45-degree field of view; color fundus image
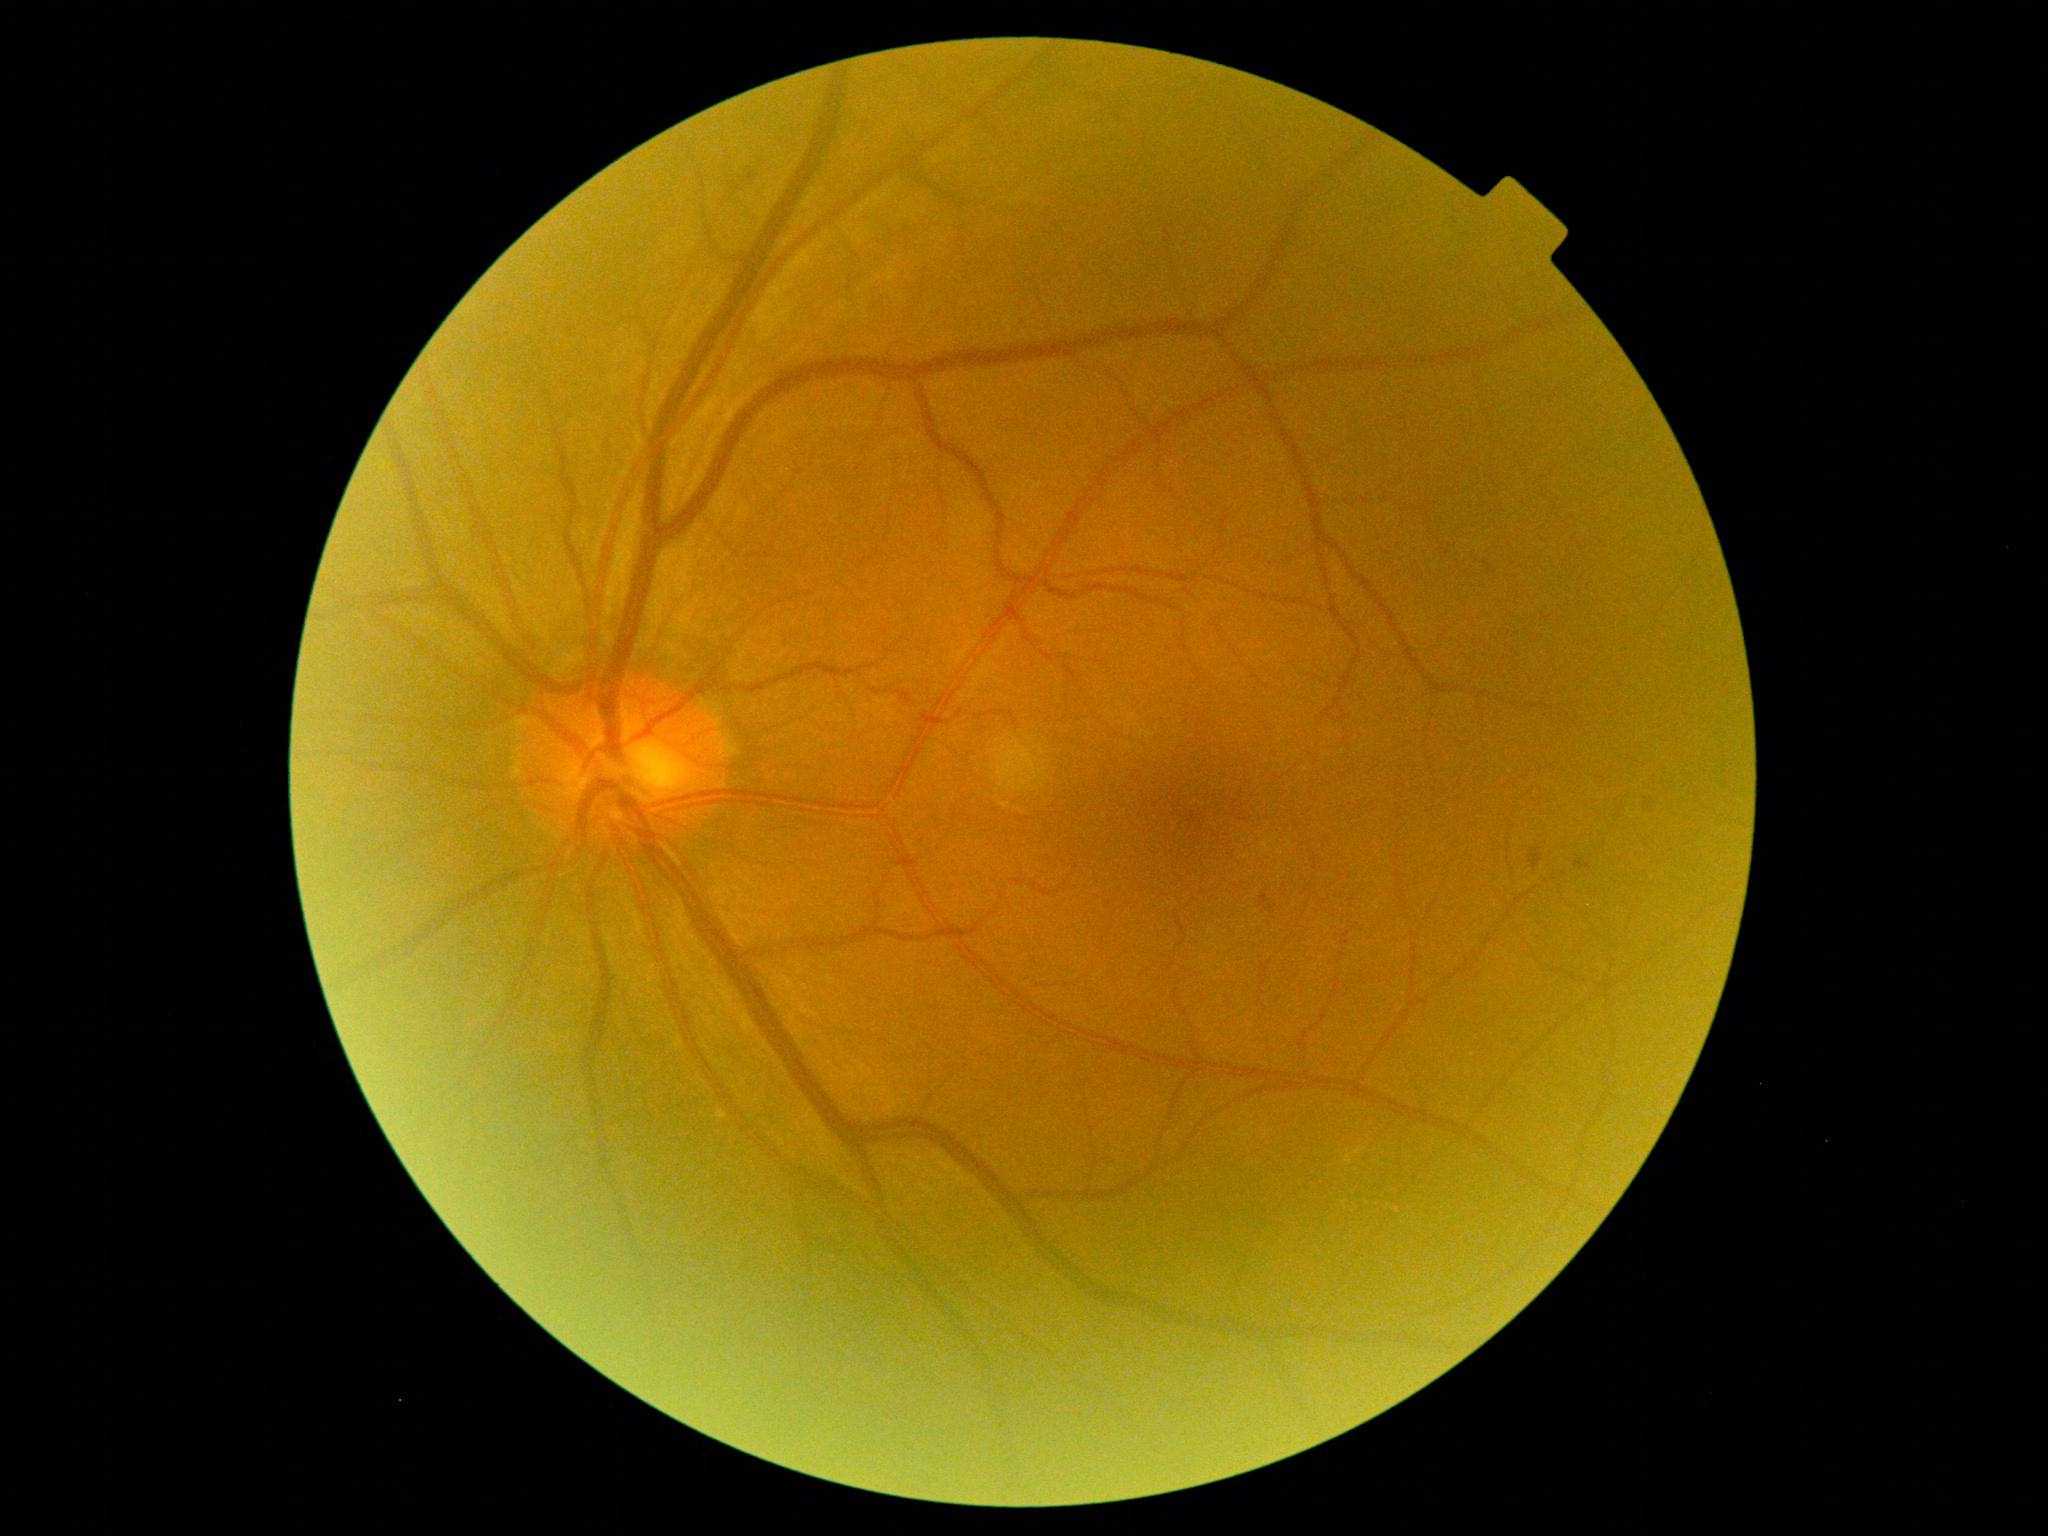 Findings:
- DR: grade 1